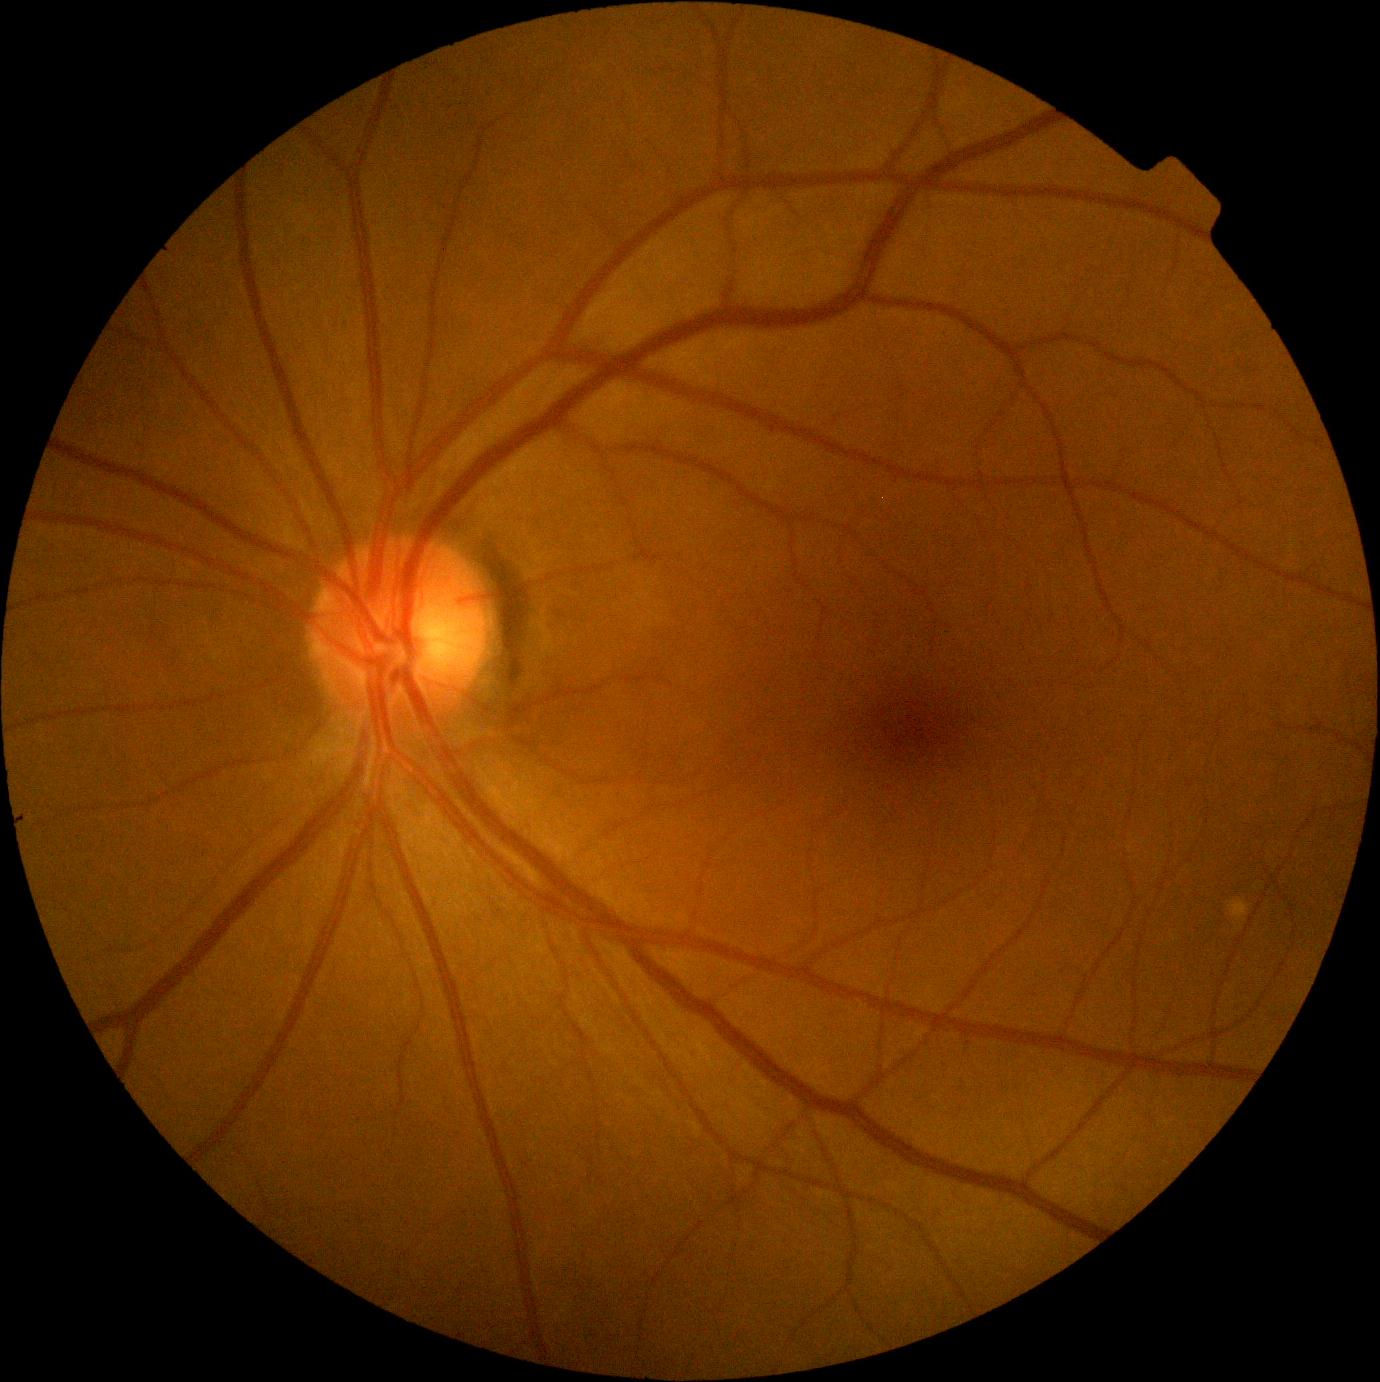
No diabetic retinal disease findings. Retinopathy grade is 0.